45° FOV, image size 2212x1659: 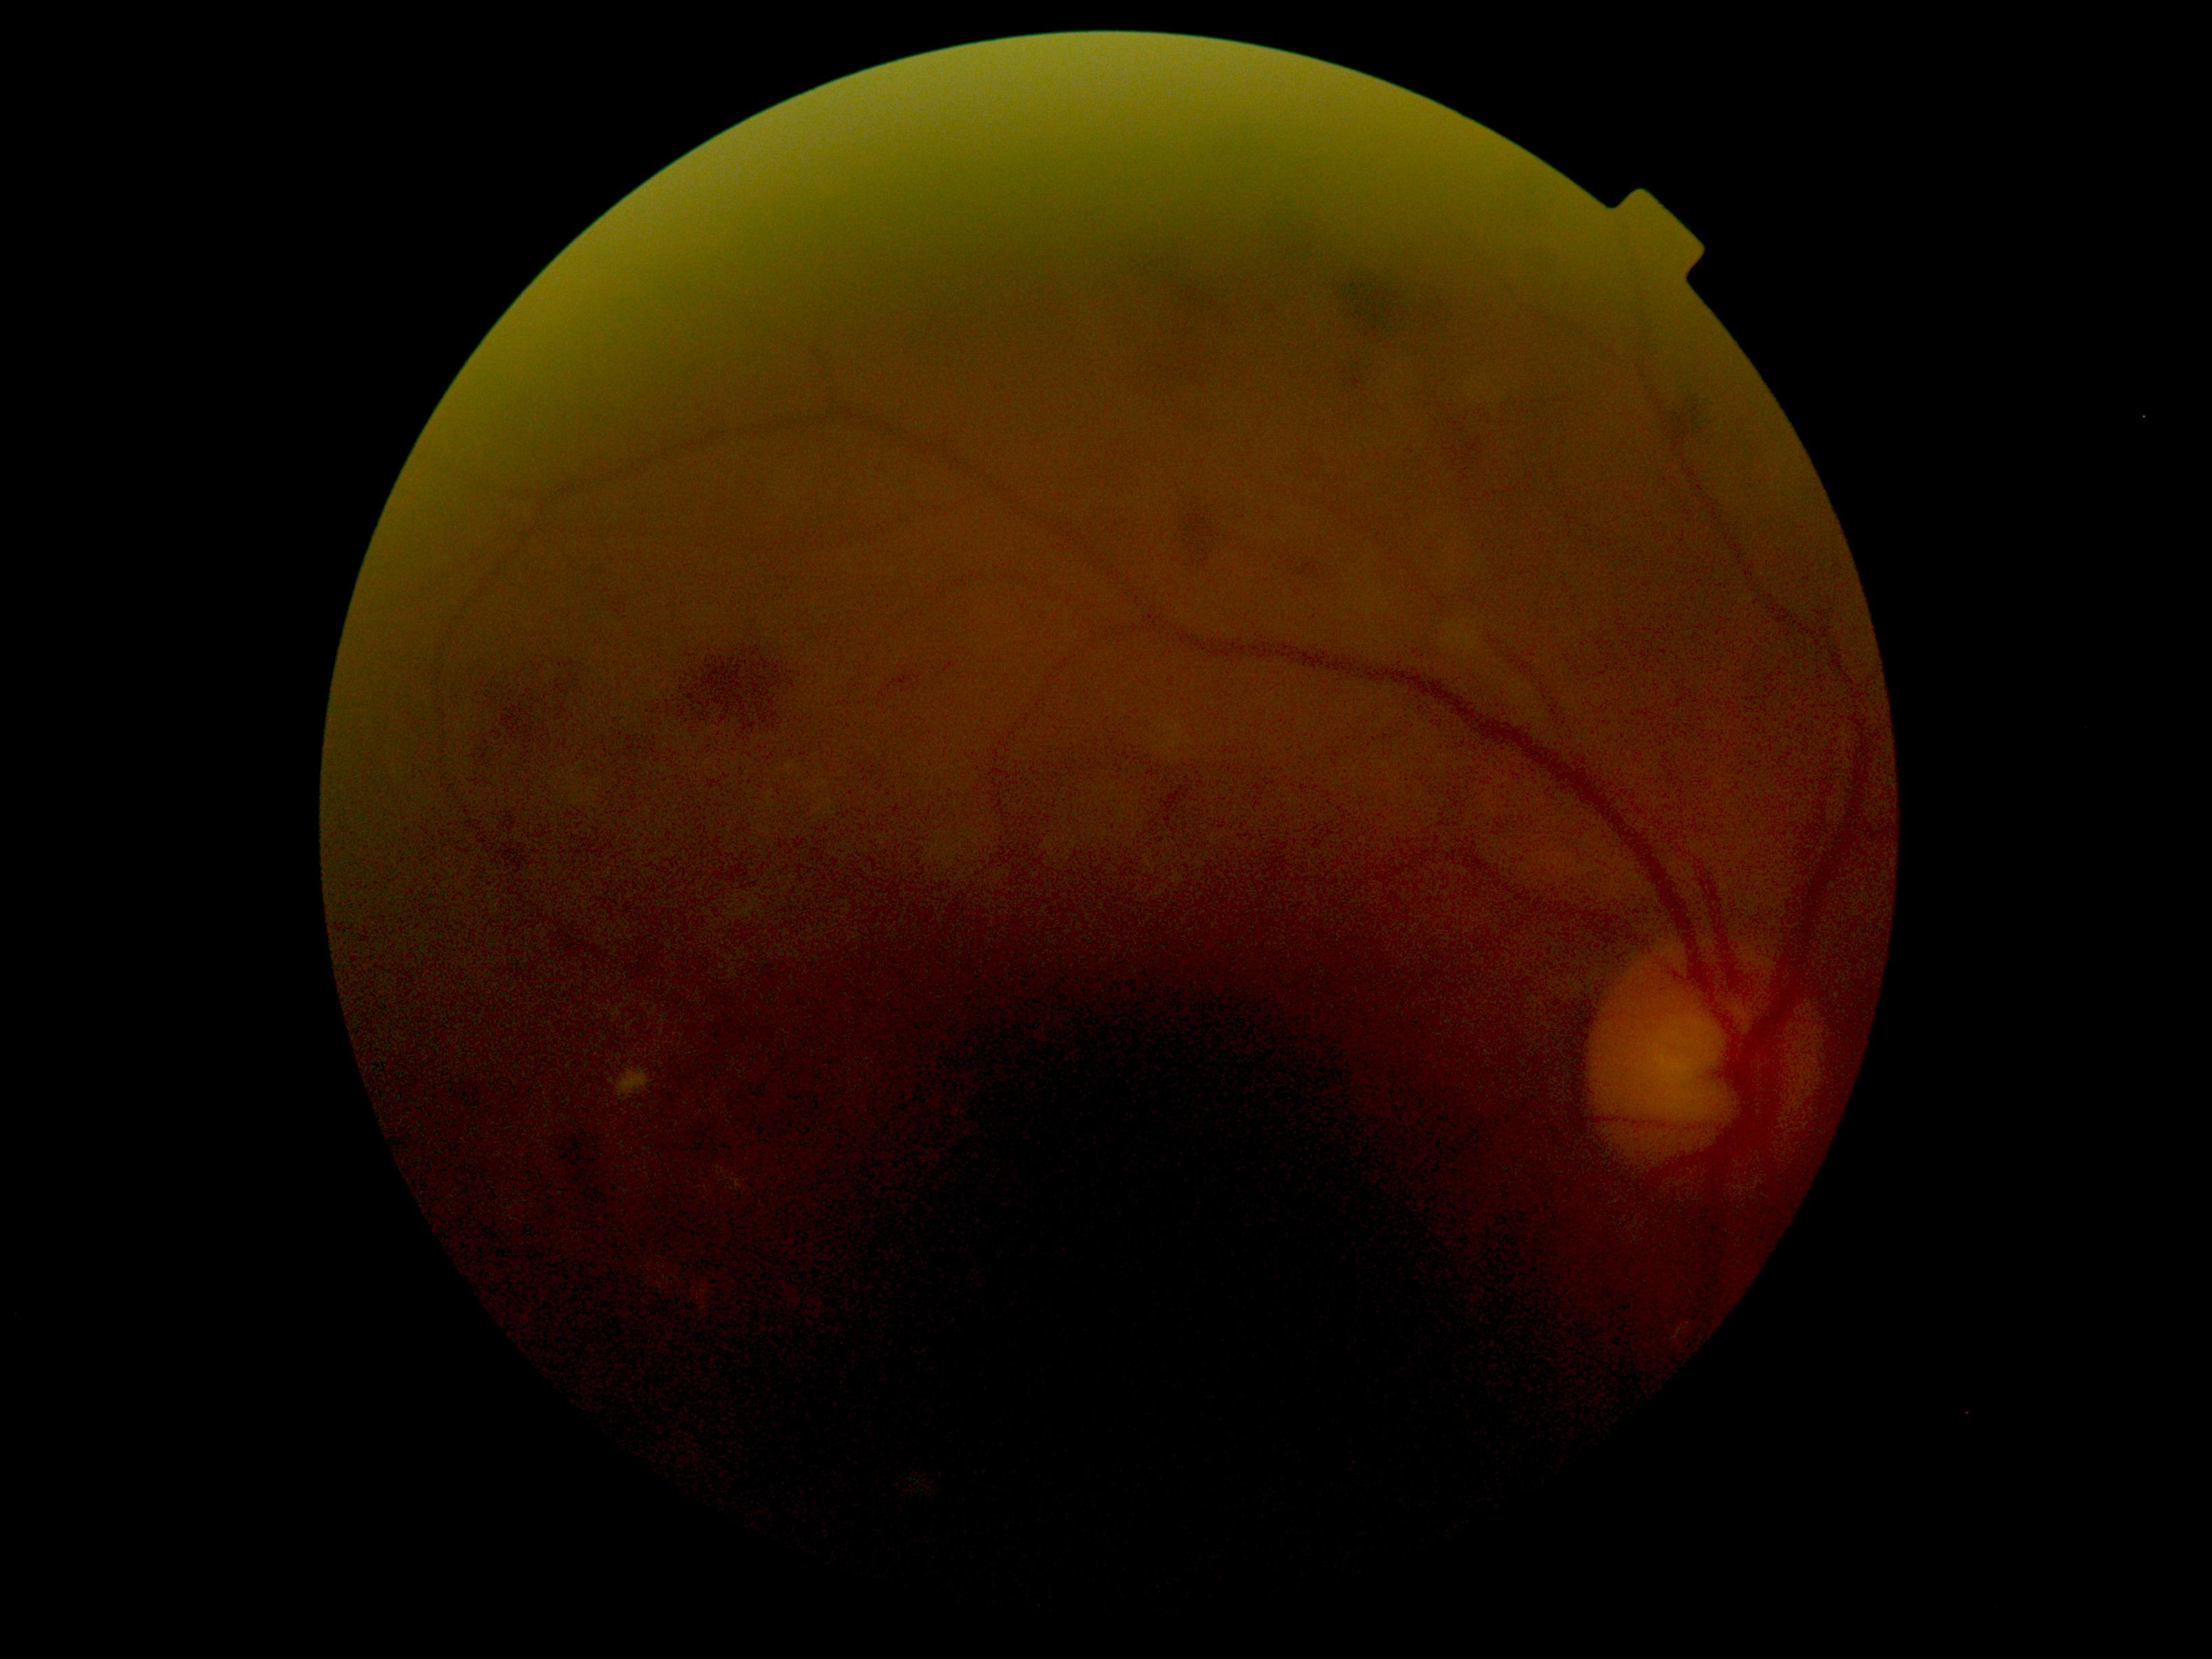

diabetic retinopathy = grade 2 (moderate NPDR)
DR class = non-proliferative diabetic retinopathy